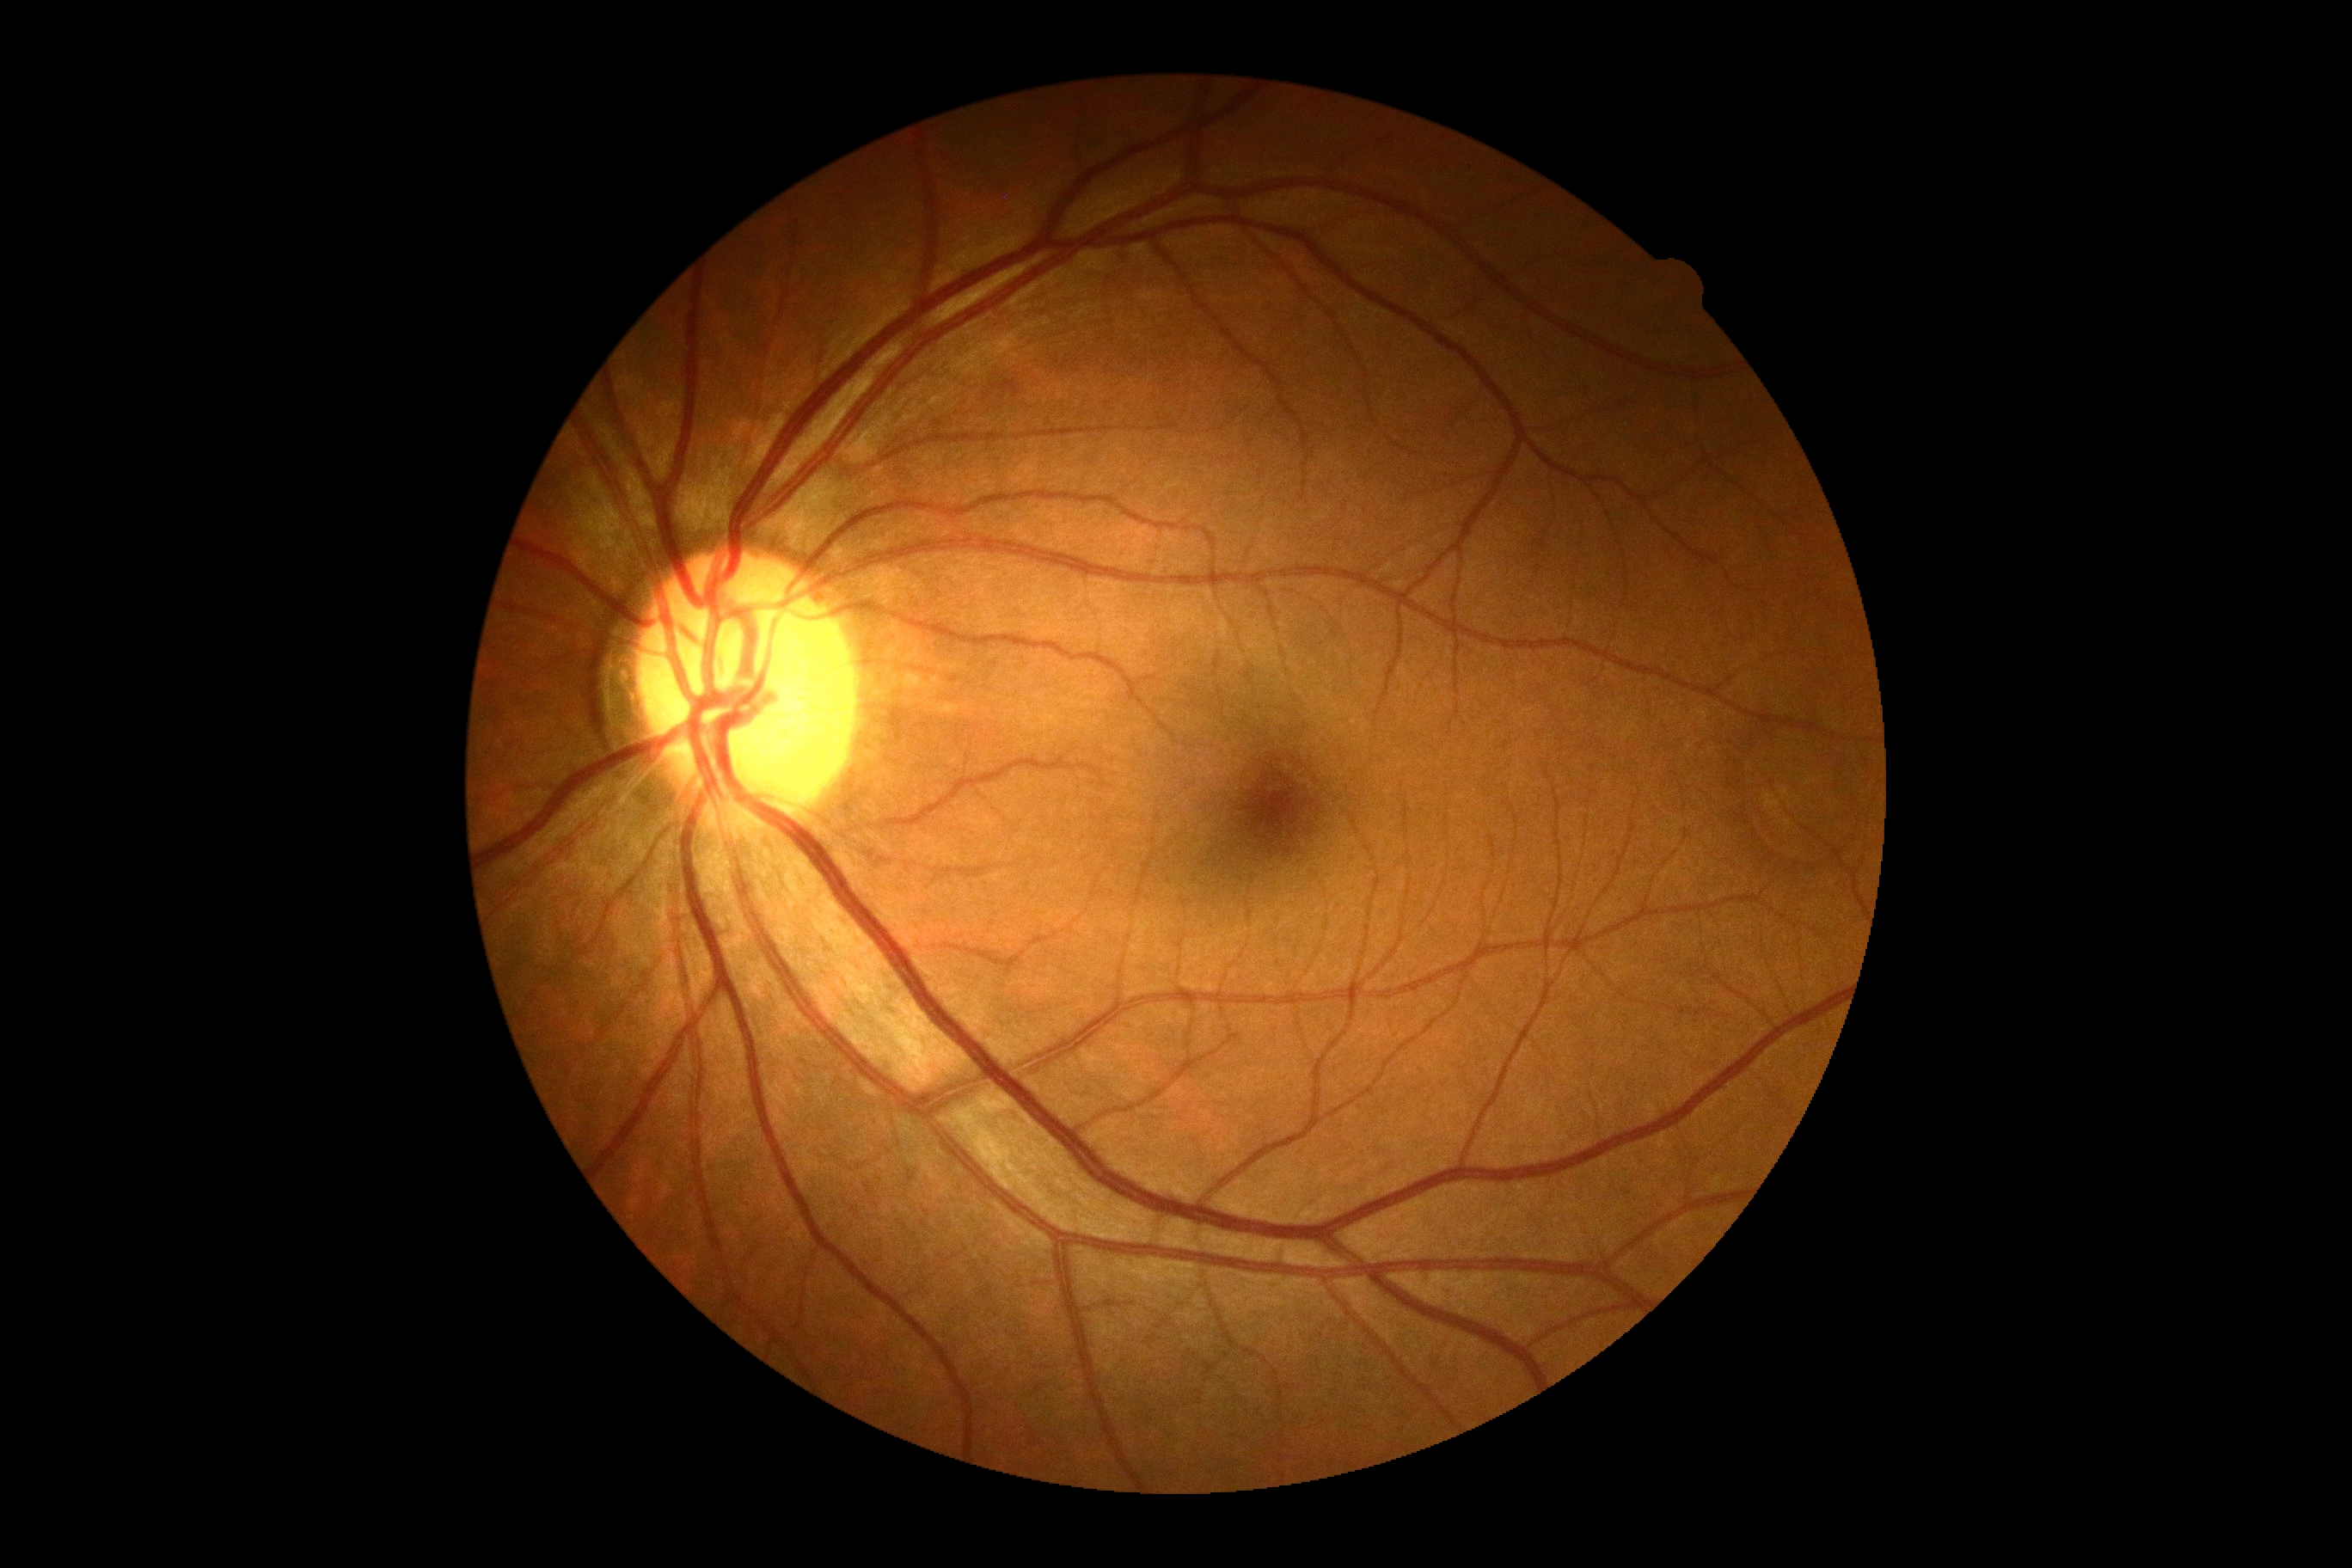
No apparent diabetic retinopathy.
DR severity is 0.